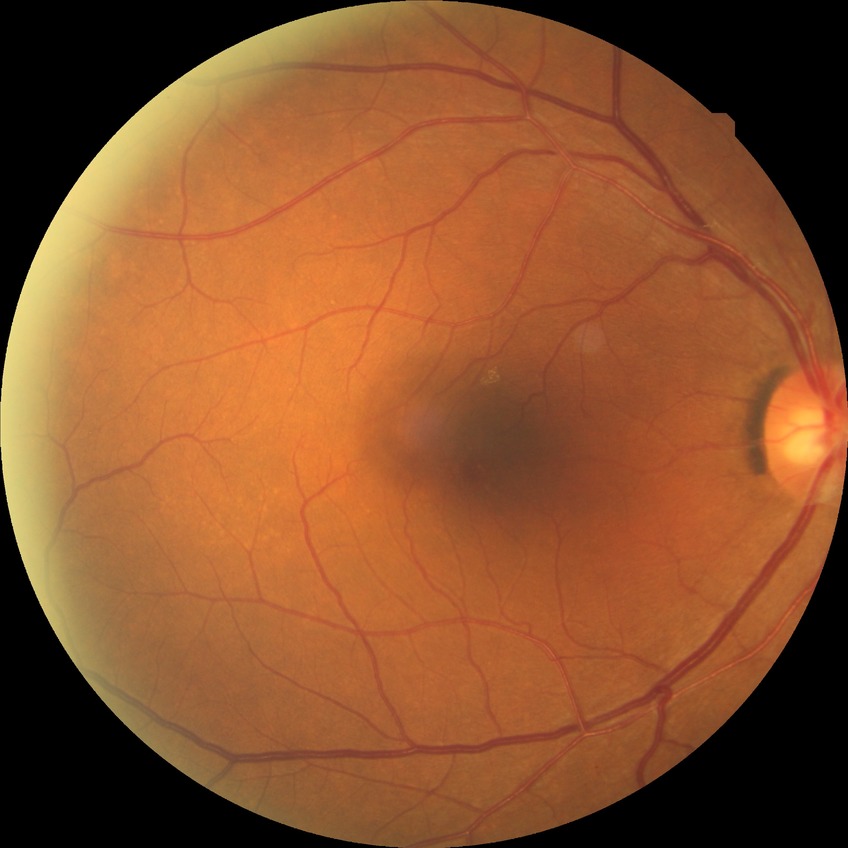

DR stage: NDR.